Phoenix ICON wide-field infant fundus image; Phoenix ICON, 100° FOV.
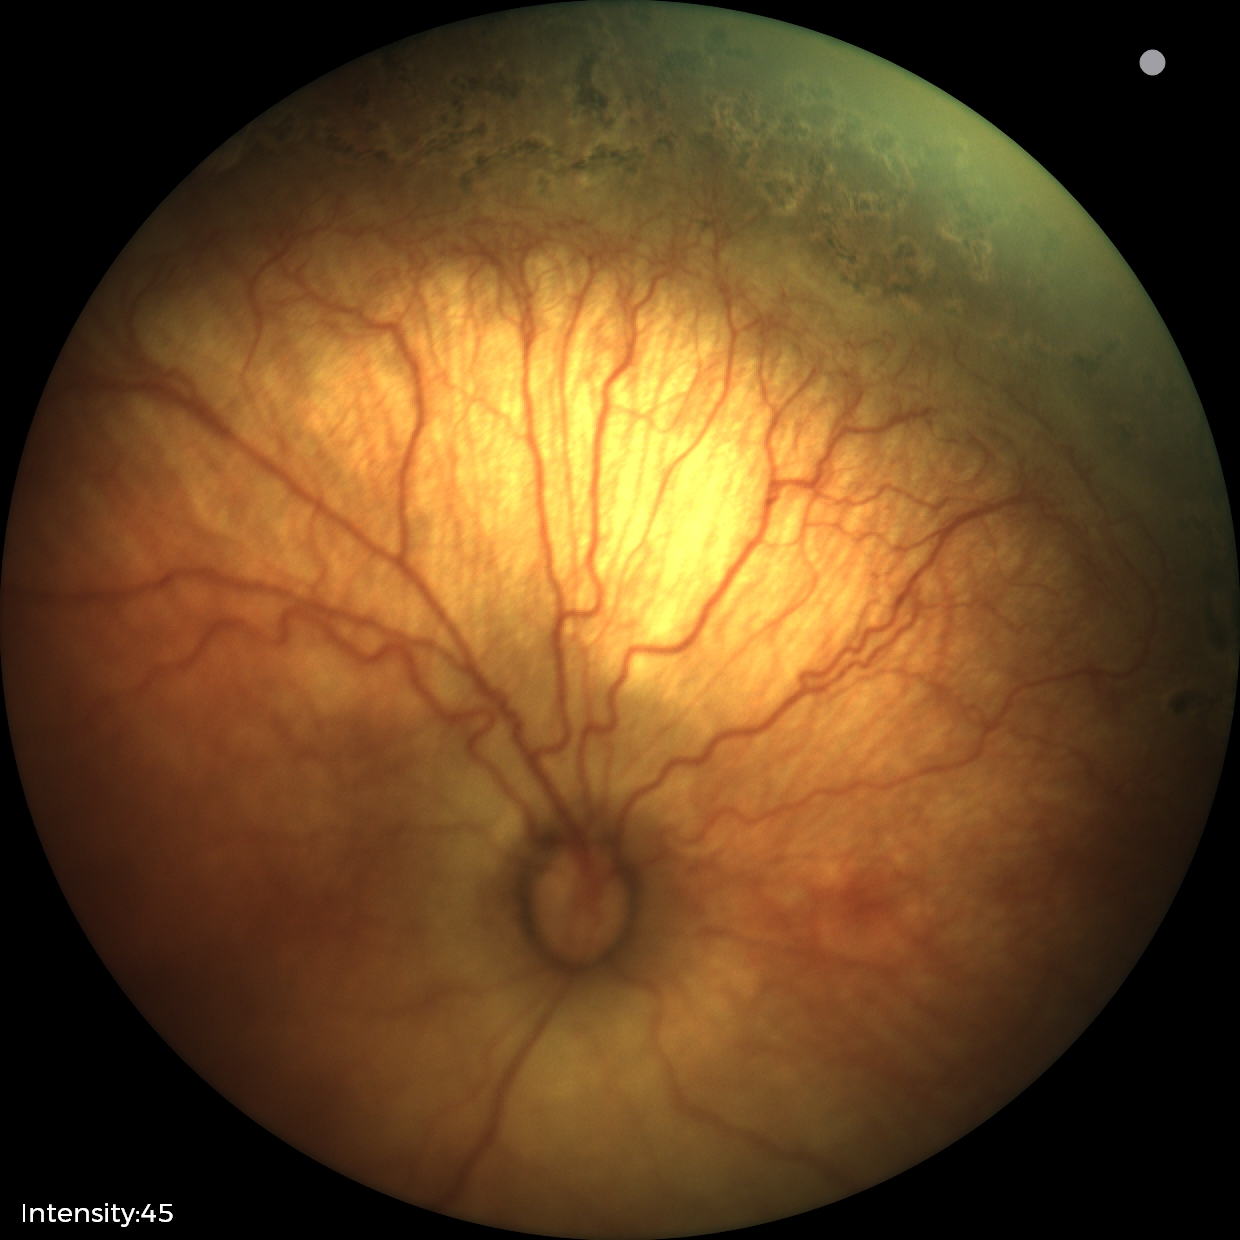 Plus disease absent. From an examination with diagnosis of status post ROP.